45 degree fundus photograph: 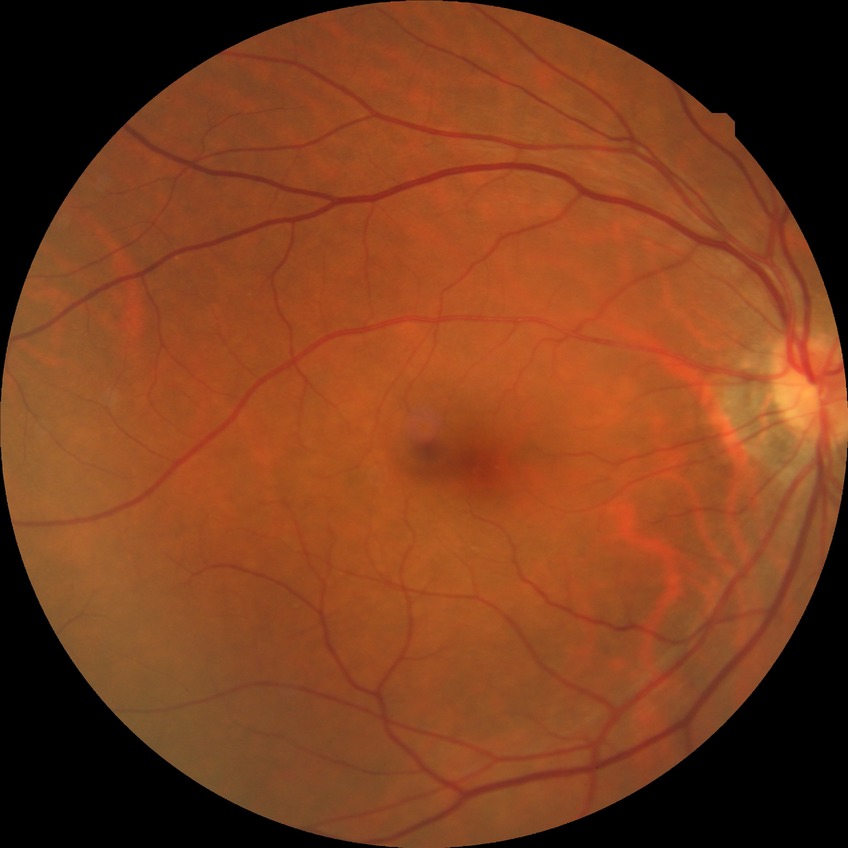 Diabetic retinopathy (DR) is no diabetic retinopathy (NDR).